CFP · 45° field of view · image size 1932x1910 — 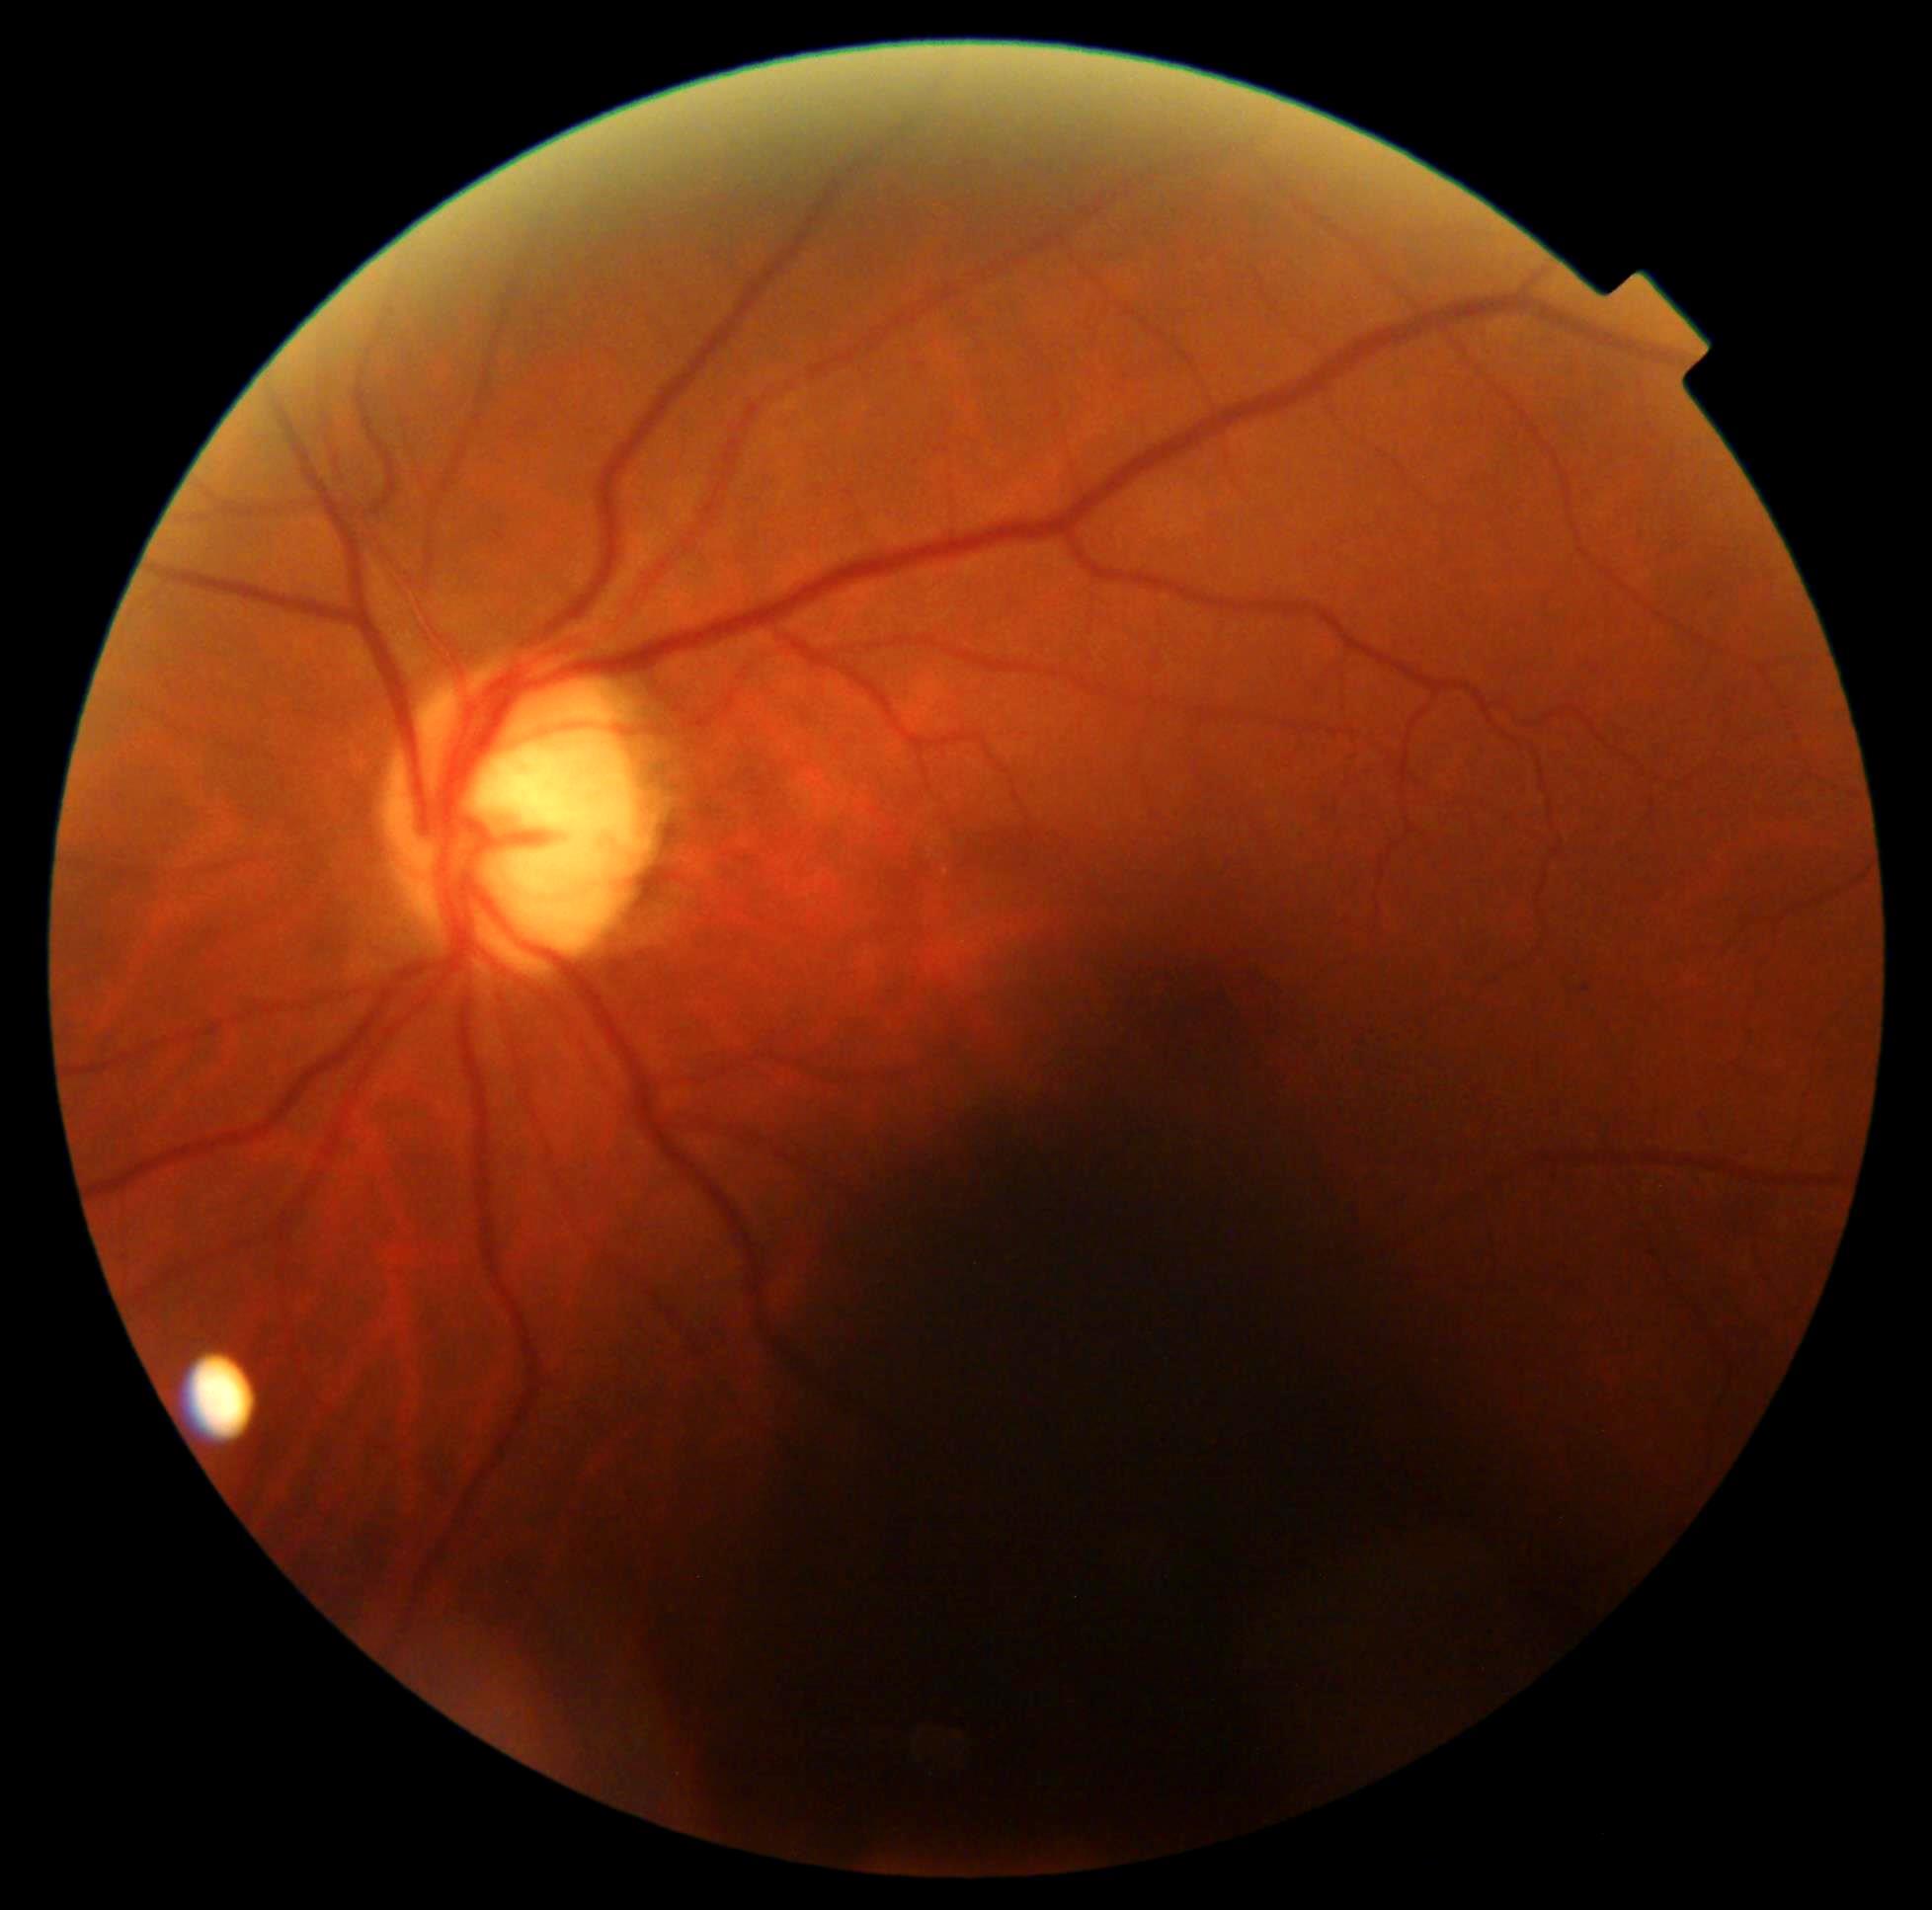
The retinopathy is classified as non-proliferative diabetic retinopathy. DR is mild NPDR (grade 1).